848 by 848 pixels — 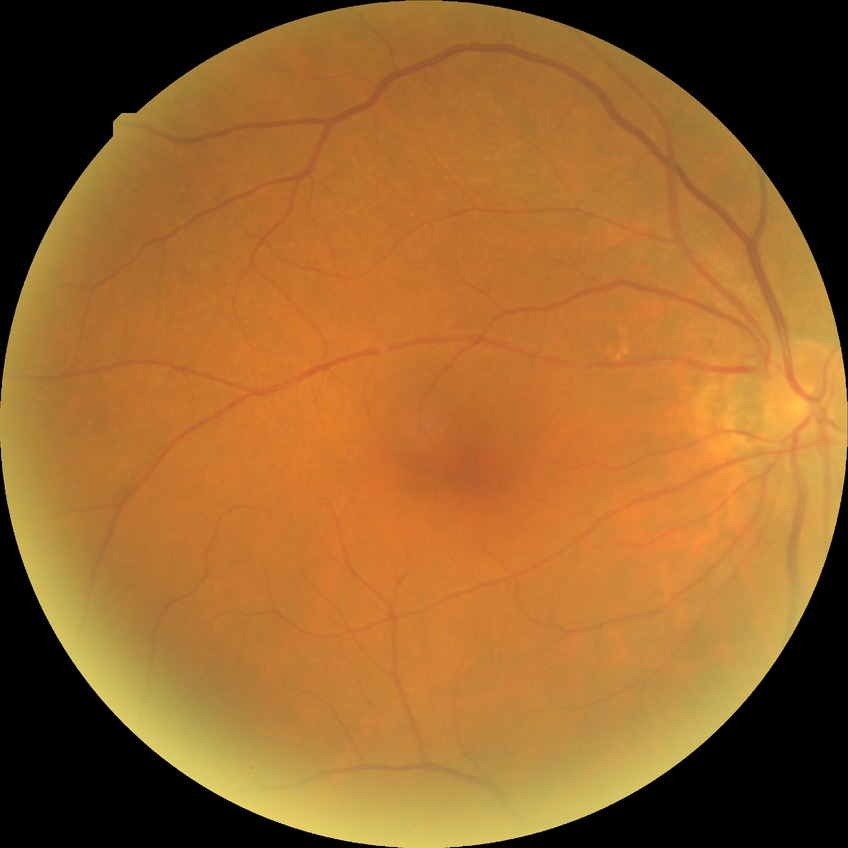 Diabetic retinopathy (DR): NDR (no diabetic retinopathy).